Clarity RetCam 3, 130° FOV; infant wide-field fundus photograph:
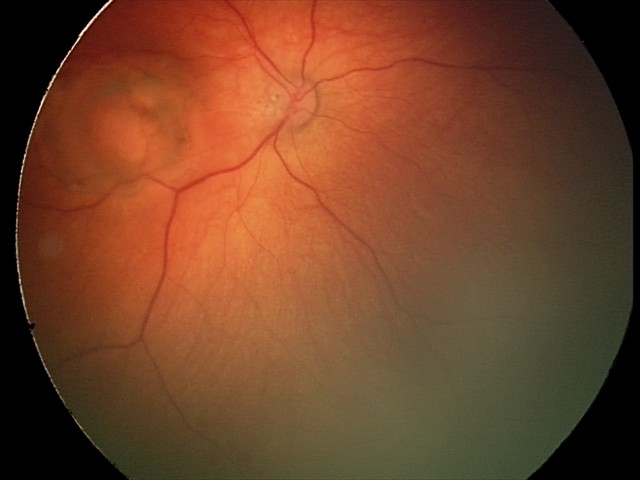

From an examination with diagnosis of toxoplasmosis chorioretinitis.